Pediatric wide-field fundus photograph. 130° field of view (Clarity RetCam 3):
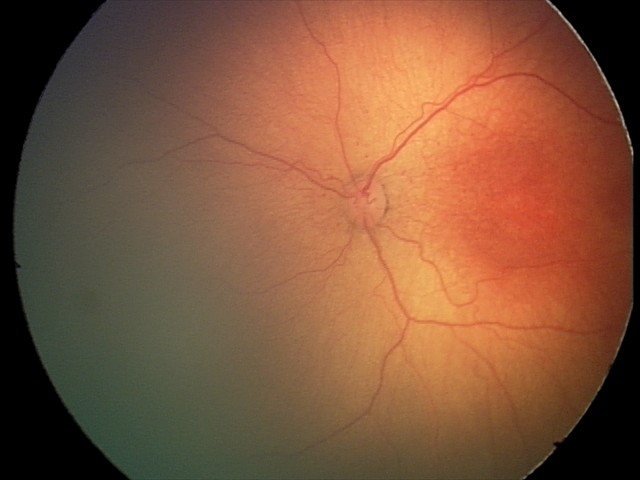
Plus disease absent. Screening examination consistent with ROP stage 2.